NIDEK AFC-230 fundus camera, FOV: 45 degrees, CFP.
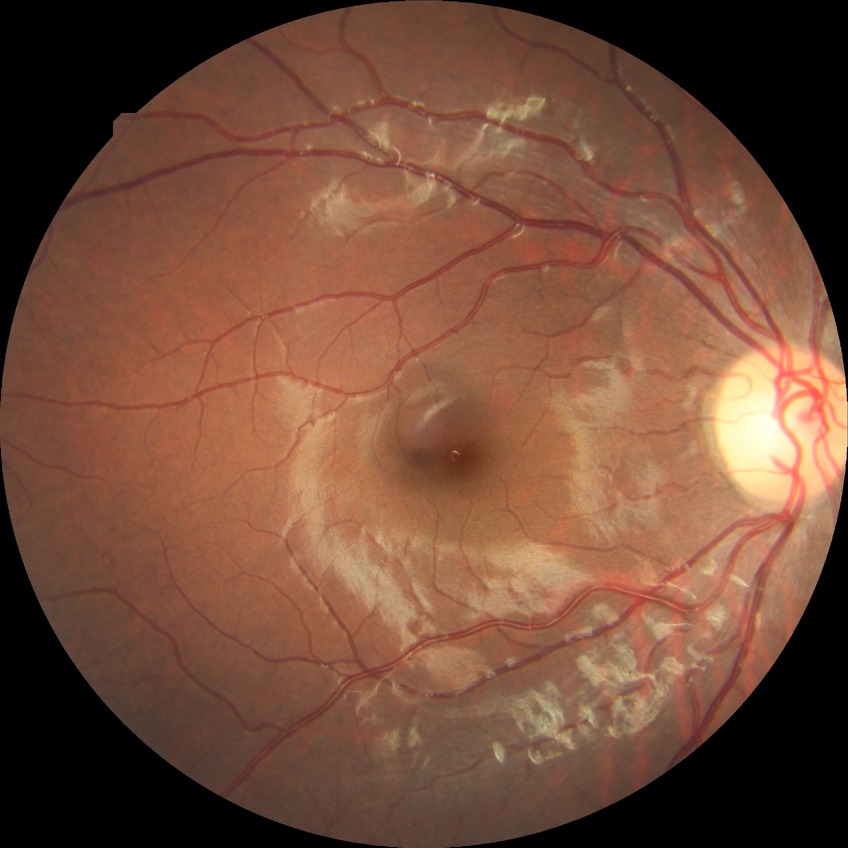 Davis grading: no diabetic retinopathy.